Field includes the optic disc and macula
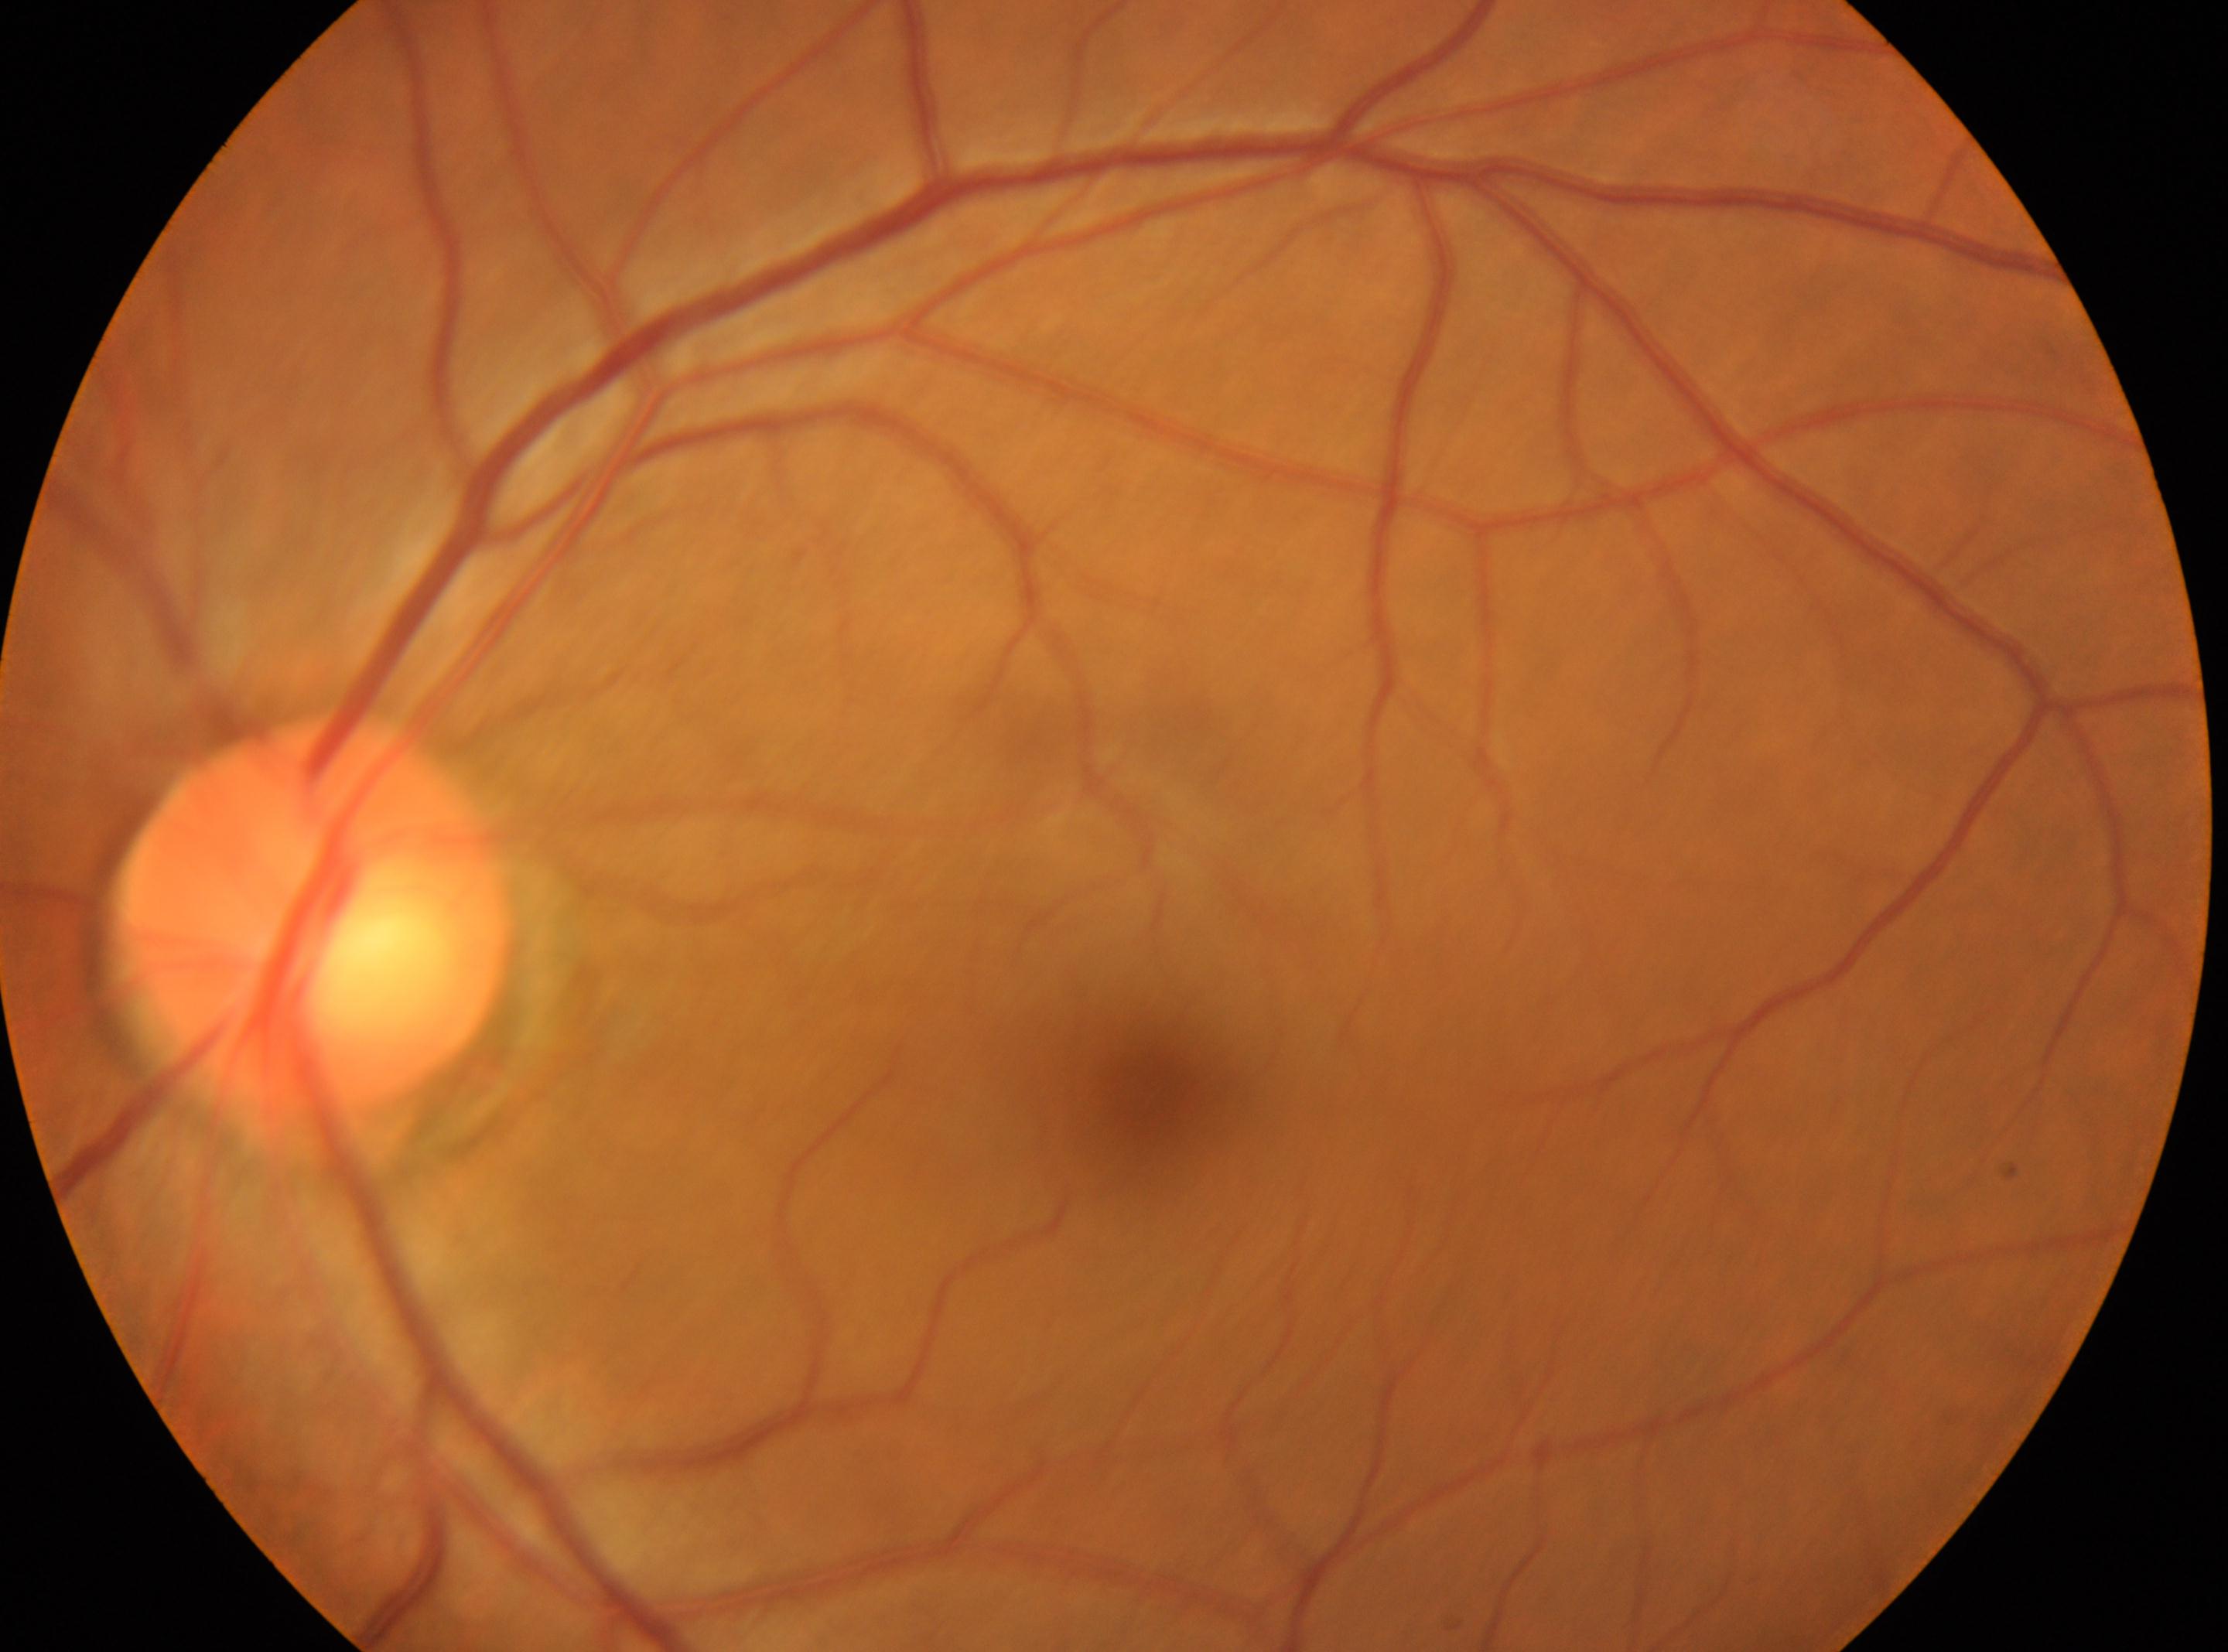 disc center = (x=312, y=914) | laterality = left | DR stage = grade 0 (no apparent retinopathy) | fovea centralis = (x=1148, y=1098).